45° field of view — 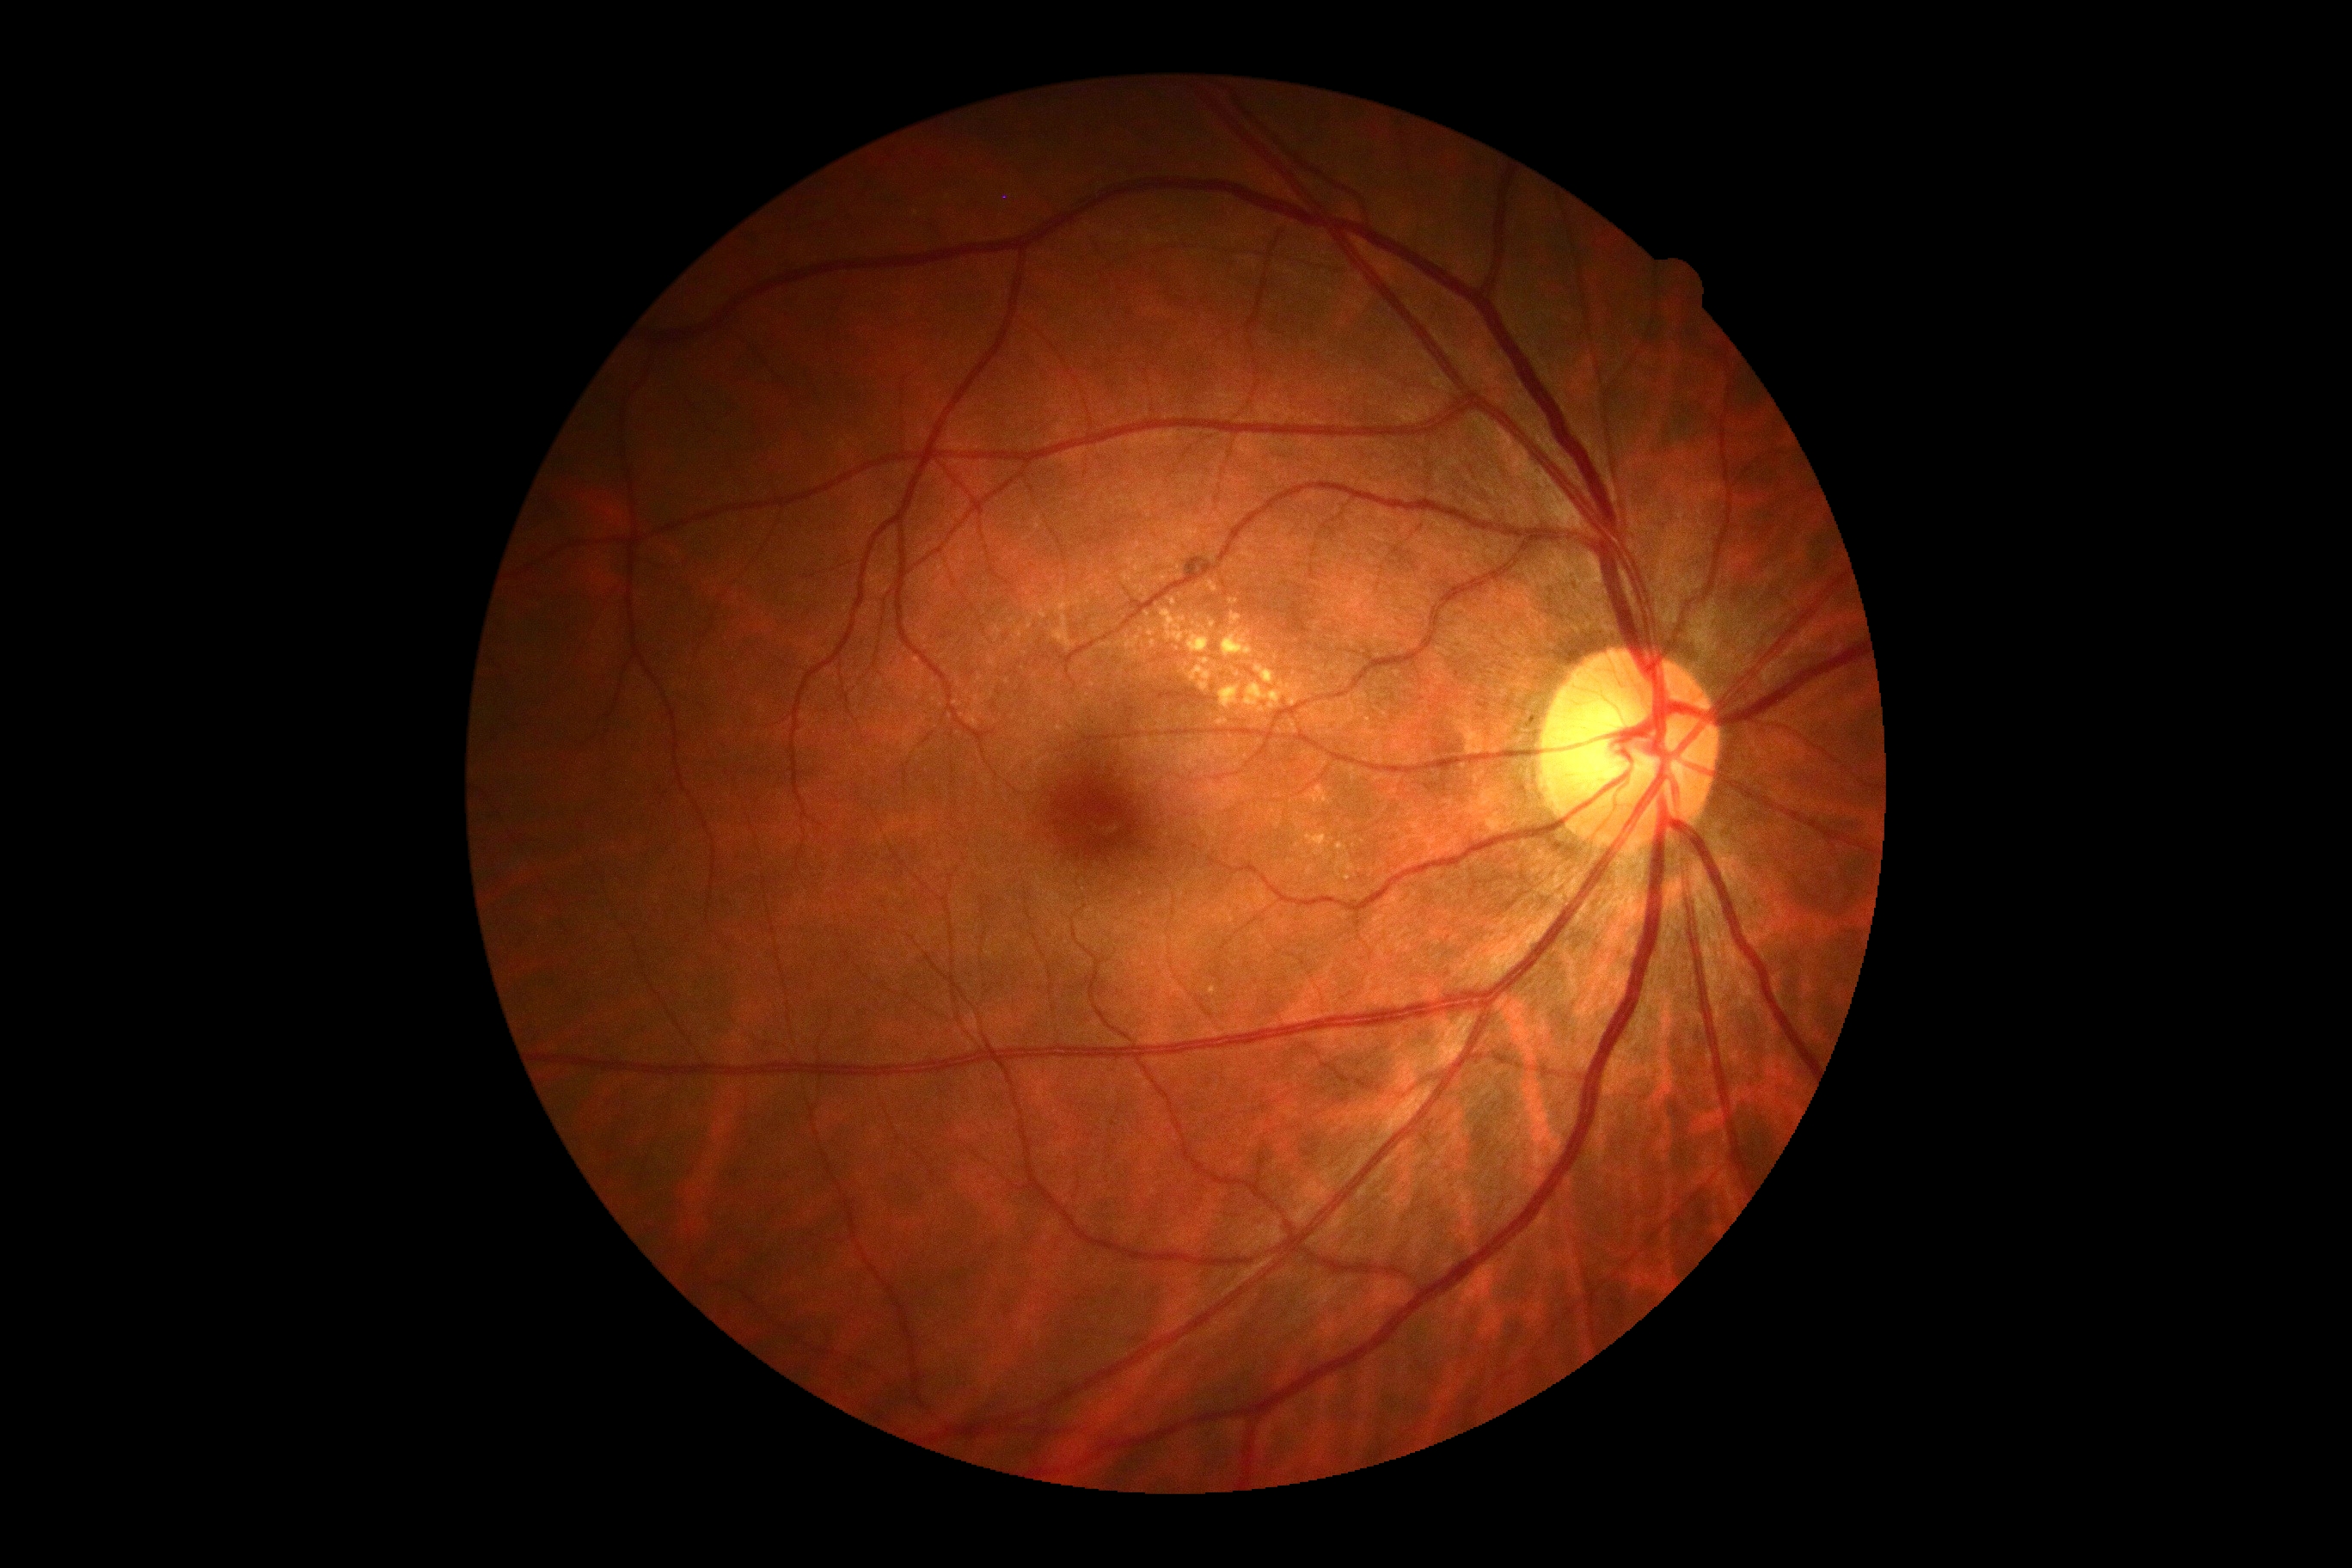

Diabetic retinopathy (DR) is moderate non-proliferative diabetic retinopathy (grade 2)
Representative lesions:
- hard exudates (EXs) (partial): (x1=1208, y1=582, x2=1218, y2=592) | (x1=1161, y1=611, x2=1185, y2=642) | (x1=1125, y1=635, x2=1141, y2=651) | (x1=1148, y1=630, x2=1156, y2=637) | (x1=1220, y1=685, x2=1242, y2=709) | (x1=1129, y1=652, x2=1139, y2=658) | (x1=1306, y1=830, x2=1335, y2=861) | (x1=1337, y1=854, x2=1356, y2=878)
- Small EXs approximately at (1262; 710) | (1121; 643) | (1213; 991) | (1238; 675) | (1347; 878)